Retinal fundus photograph · 2352 x 1568 pixels: 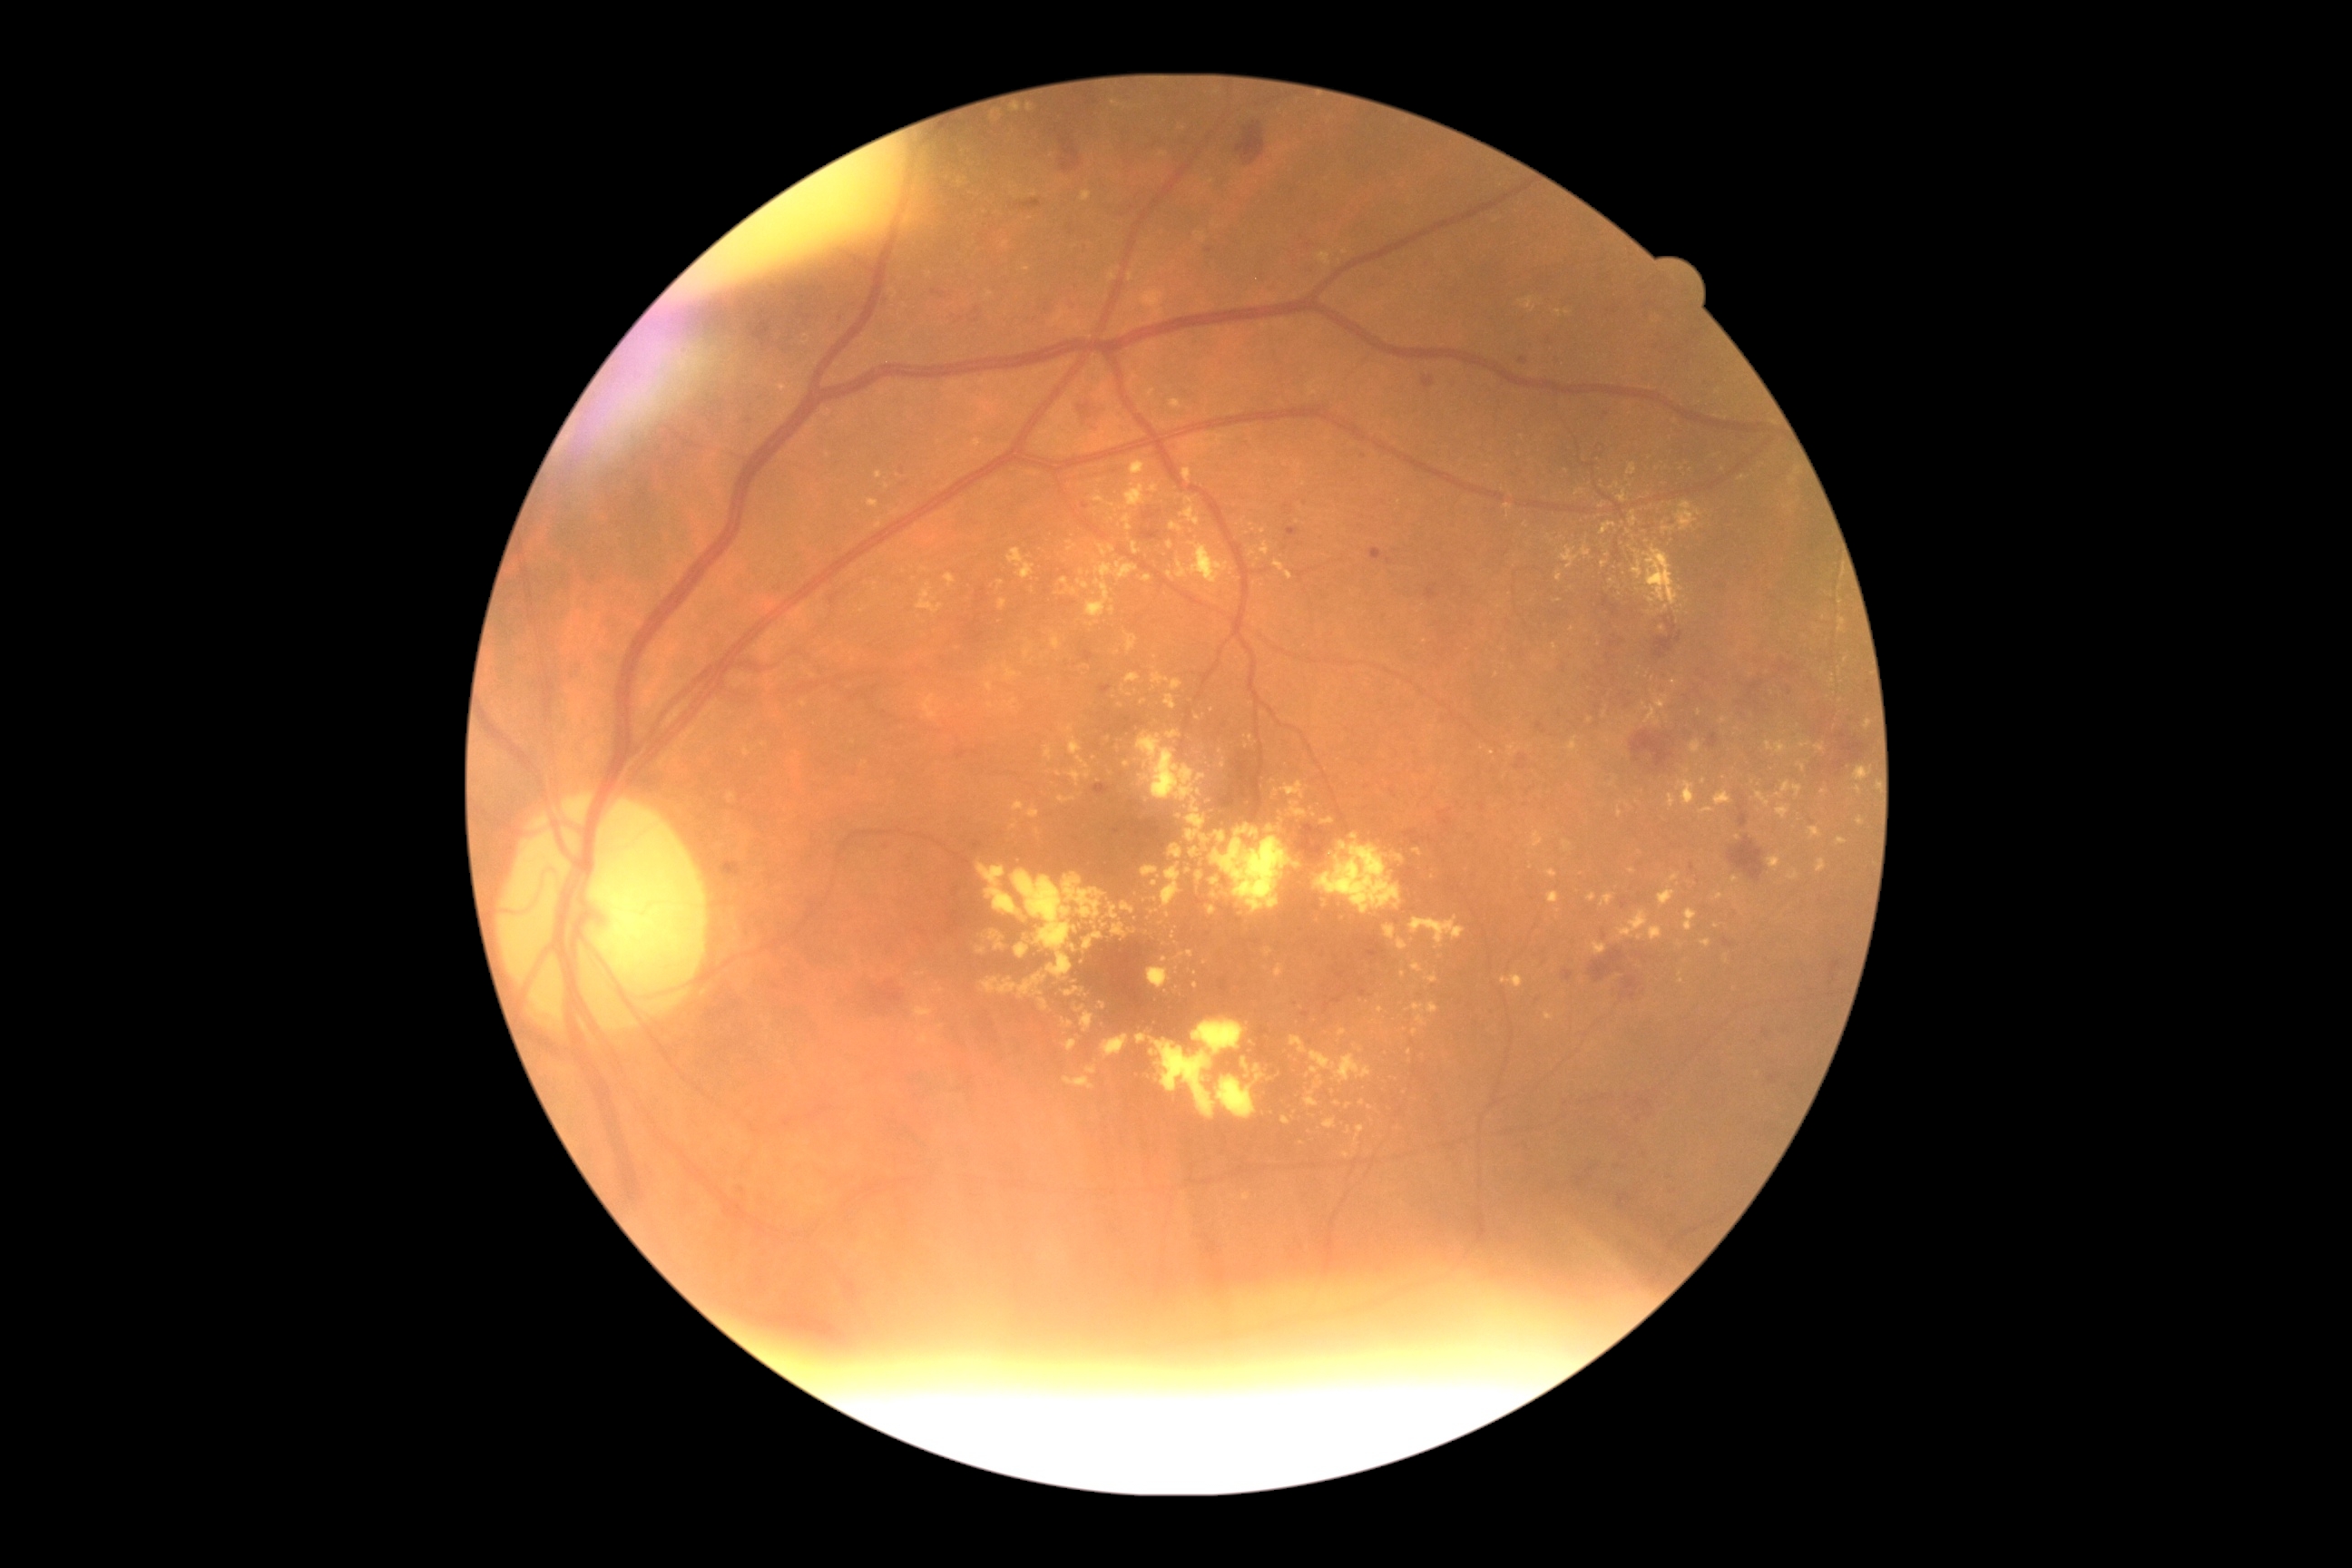

Diabetic retinopathy severity: 2; non-proliferative diabetic retinopathy
A subset of detected lesions:
hard exudates (continued) = (x1=1656, y1=696, x2=1669, y2=710), (x1=1386, y1=926, x2=1396, y2=941), (x1=1108, y1=545, x2=1115, y2=554), (x1=1587, y1=894, x2=1596, y2=903), (x1=1716, y1=790, x2=1732, y2=807), (x1=1556, y1=309, x2=1562, y2=317), (x1=1839, y1=618, x2=1847, y2=634), (x1=1618, y1=910, x2=1649, y2=939), (x1=1602, y1=896, x2=1614, y2=906), (x1=1643, y1=703, x2=1661, y2=727), (x1=1244, y1=736, x2=1253, y2=741), (x1=1765, y1=741, x2=1774, y2=752)
Hard exudates (small, approximate centers) near pt(1681, 946), pt(1263, 531), pt(1704, 782), pt(1102, 1006), pt(1065, 324), pt(1738, 838), pt(1213, 182)